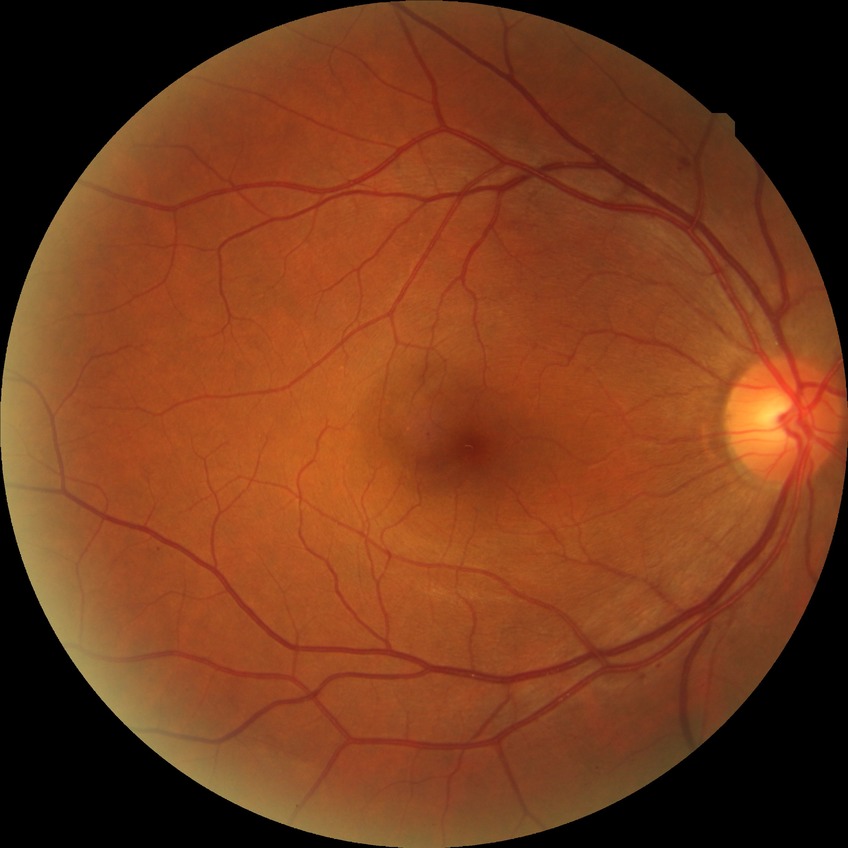

diabetic retinopathy stage = simple diabetic retinopathy.